No pharmacologic dilation, 45° field of view
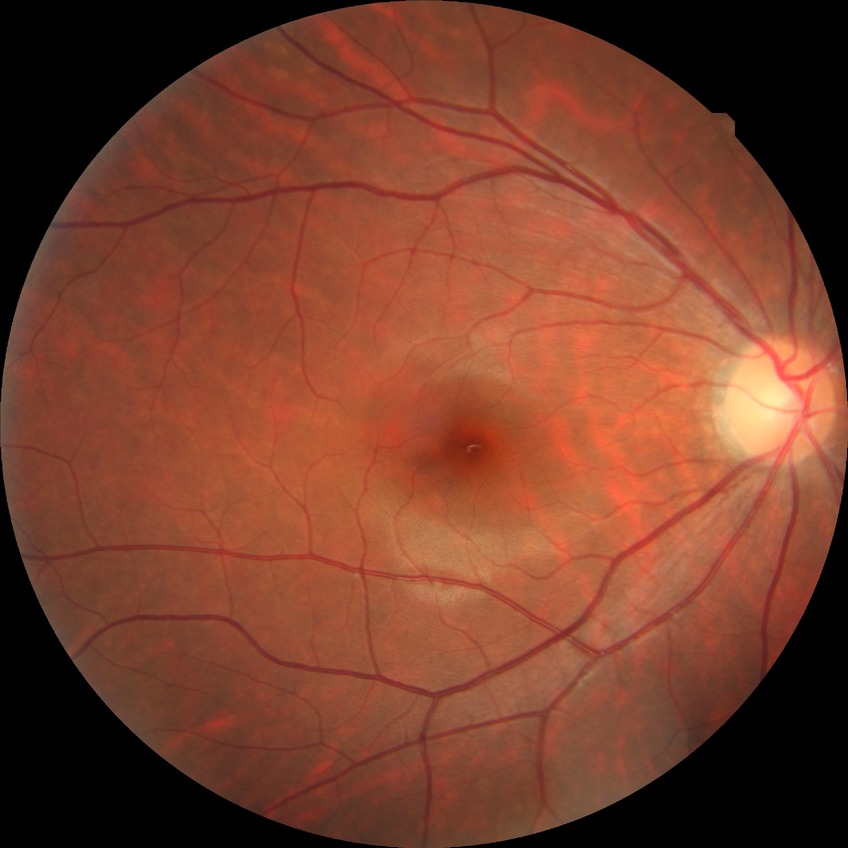   davis_grade: no diabetic retinopathy